Non-mydriatic acquisition; visual field mean defect: -3.87 dB; refractive error: +1.25 -3 × 97°; 78-year-old patient: 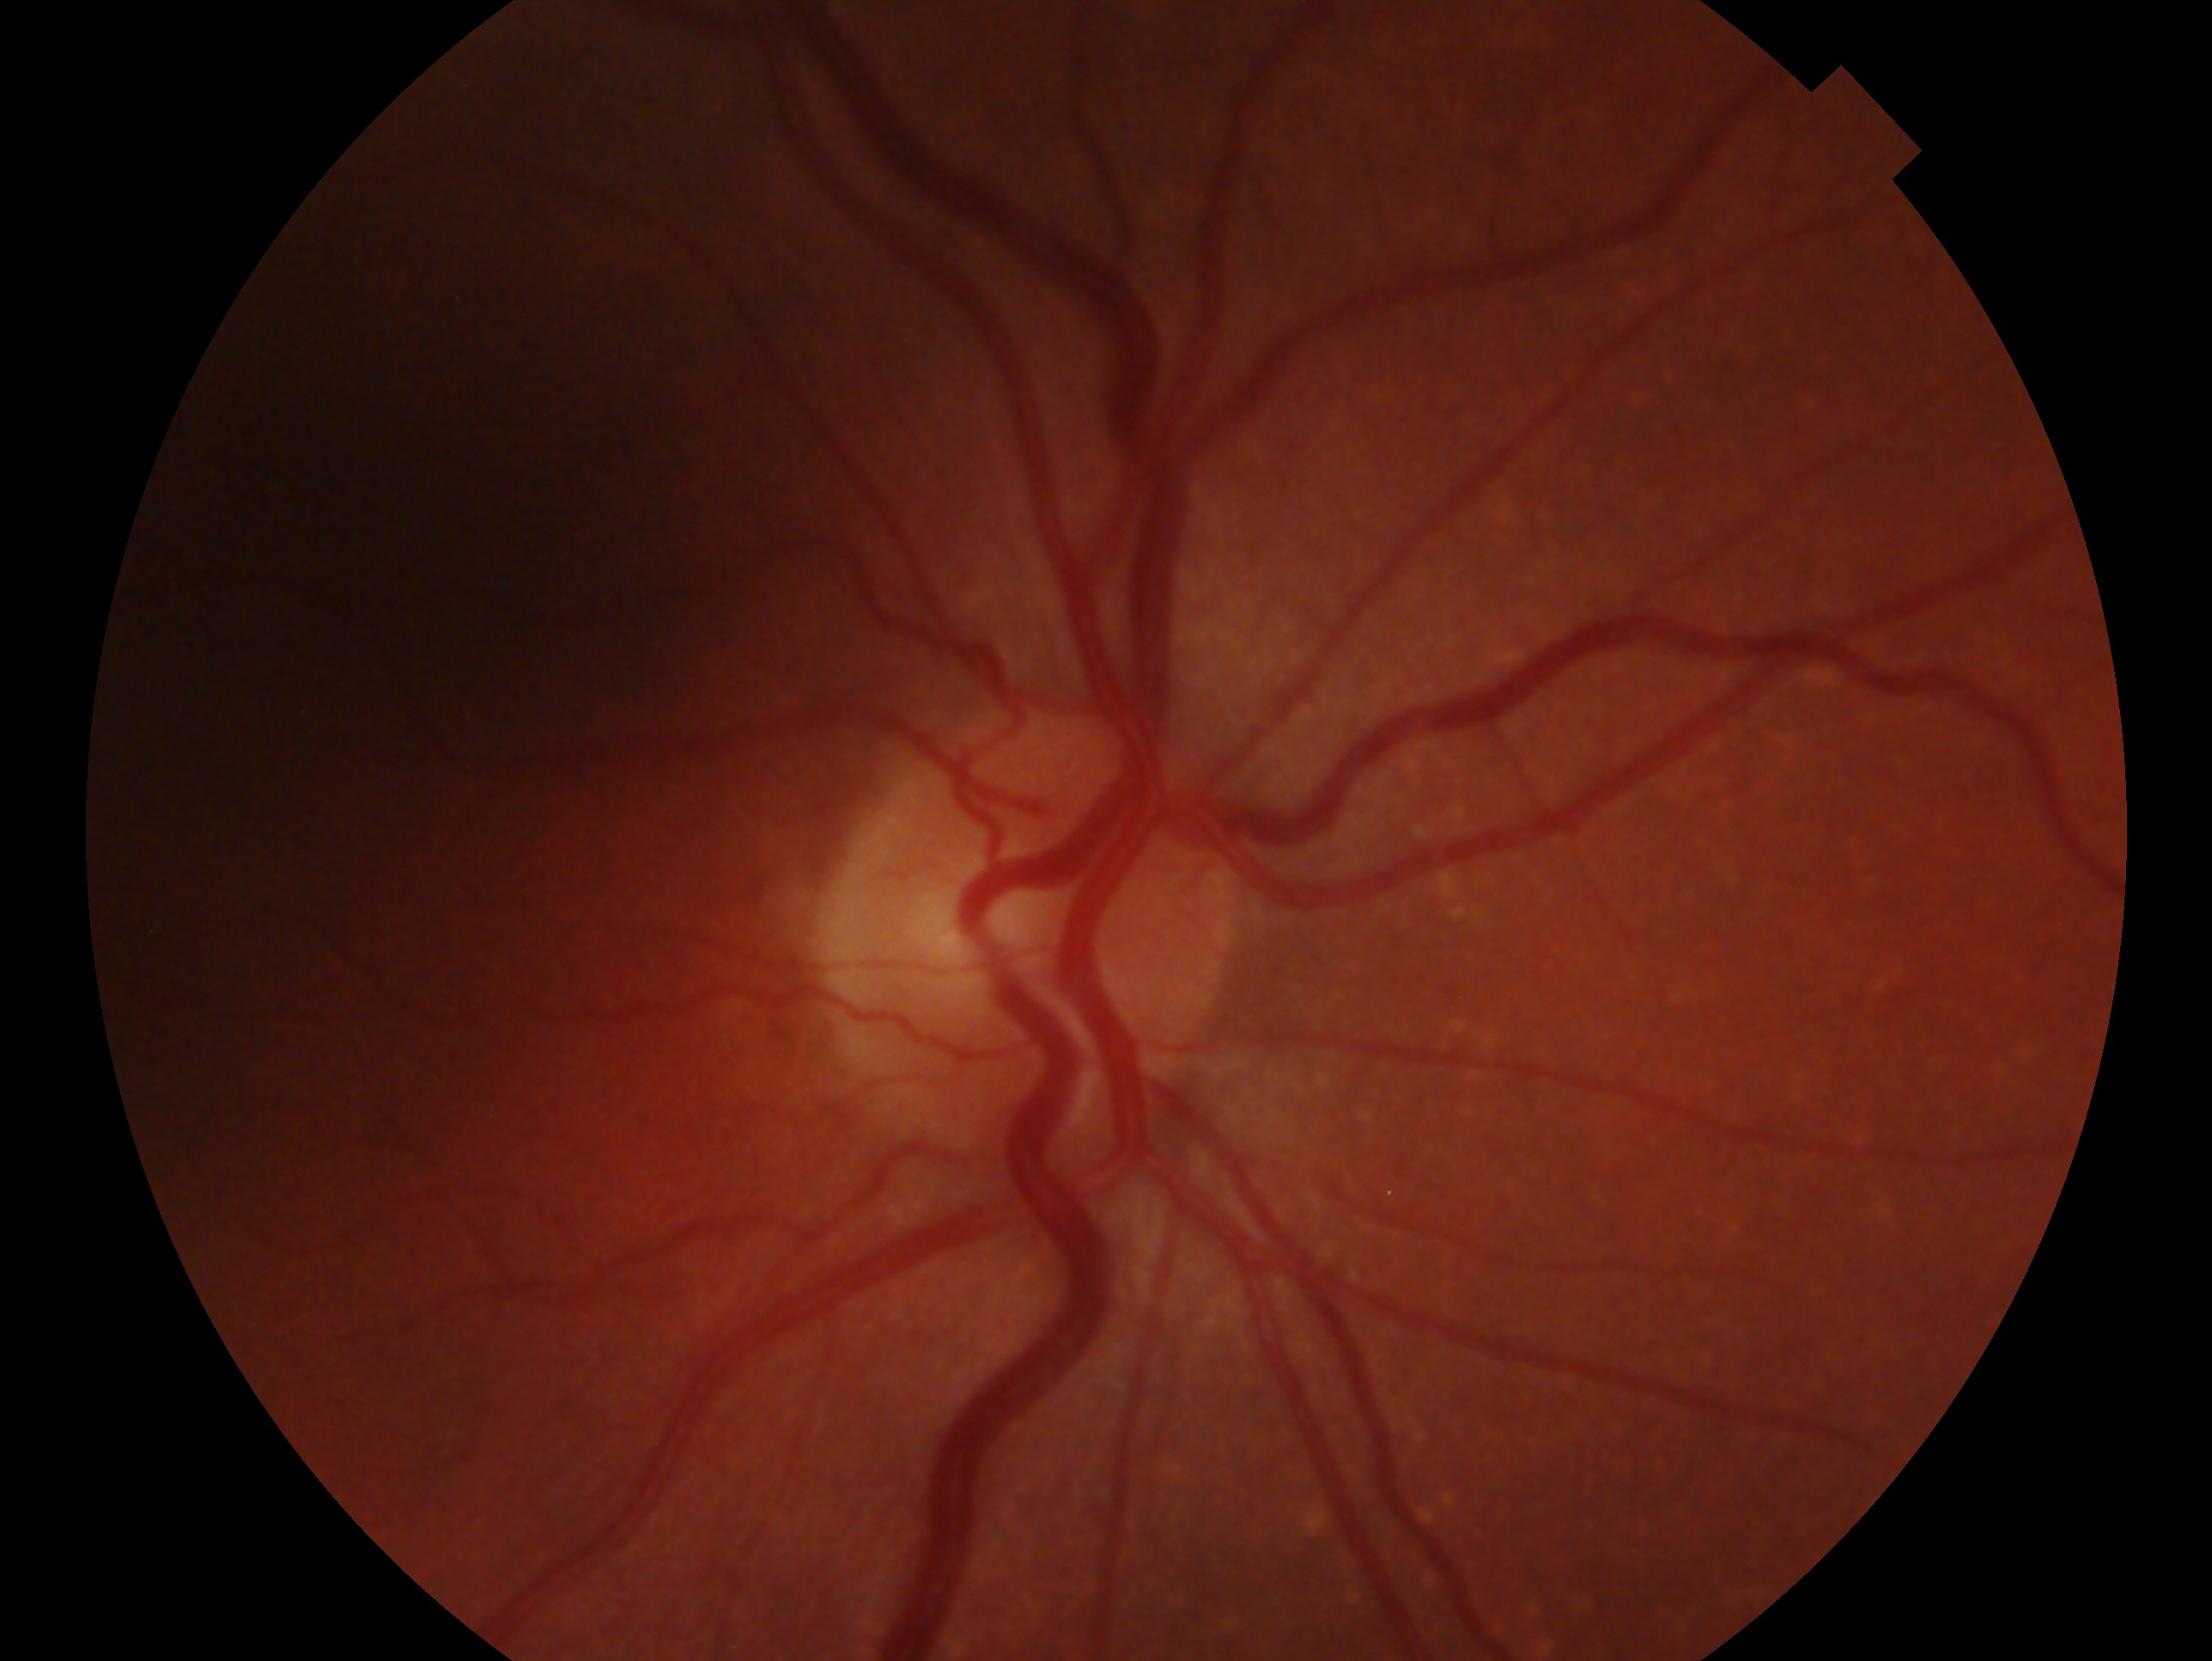 This is the right eye. Assessment: glaucoma cannot be excluded.